Color fundus photograph; captured after pupil dilation; FOV: 50 degrees — 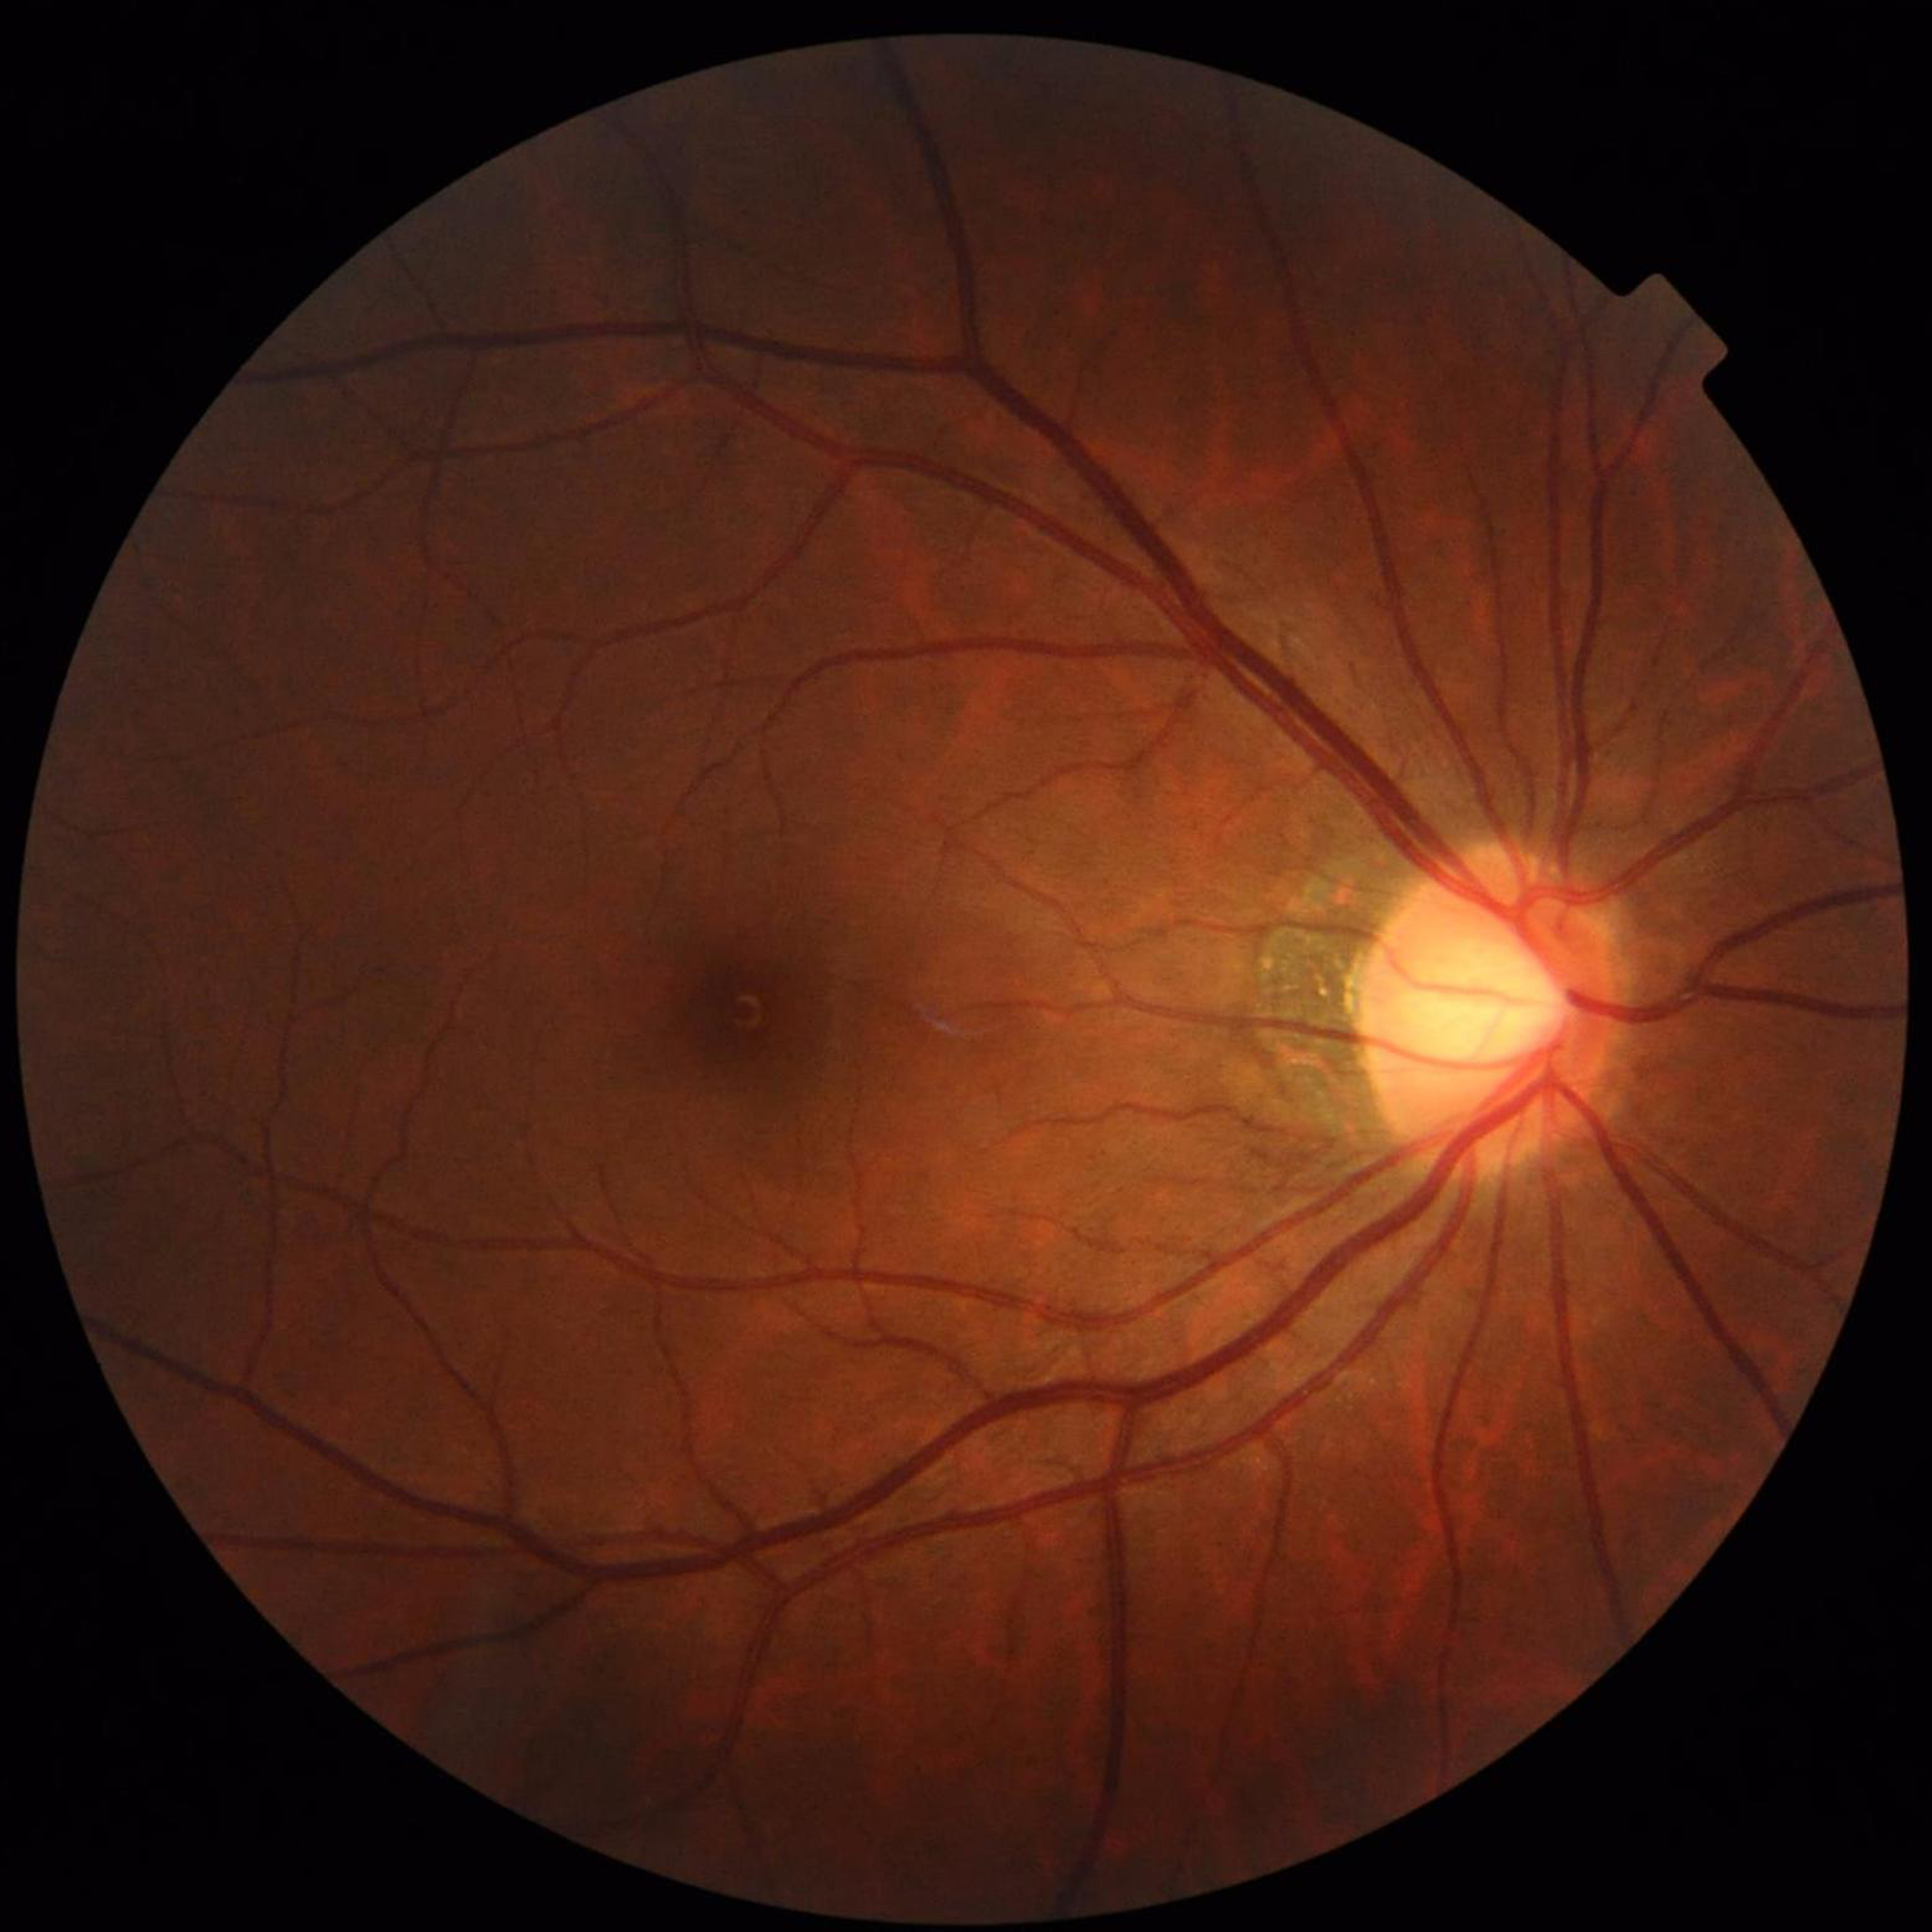

diagnosis: glaucoma